60° field of view · 2212x1659 · handheld portable fundus camera image — 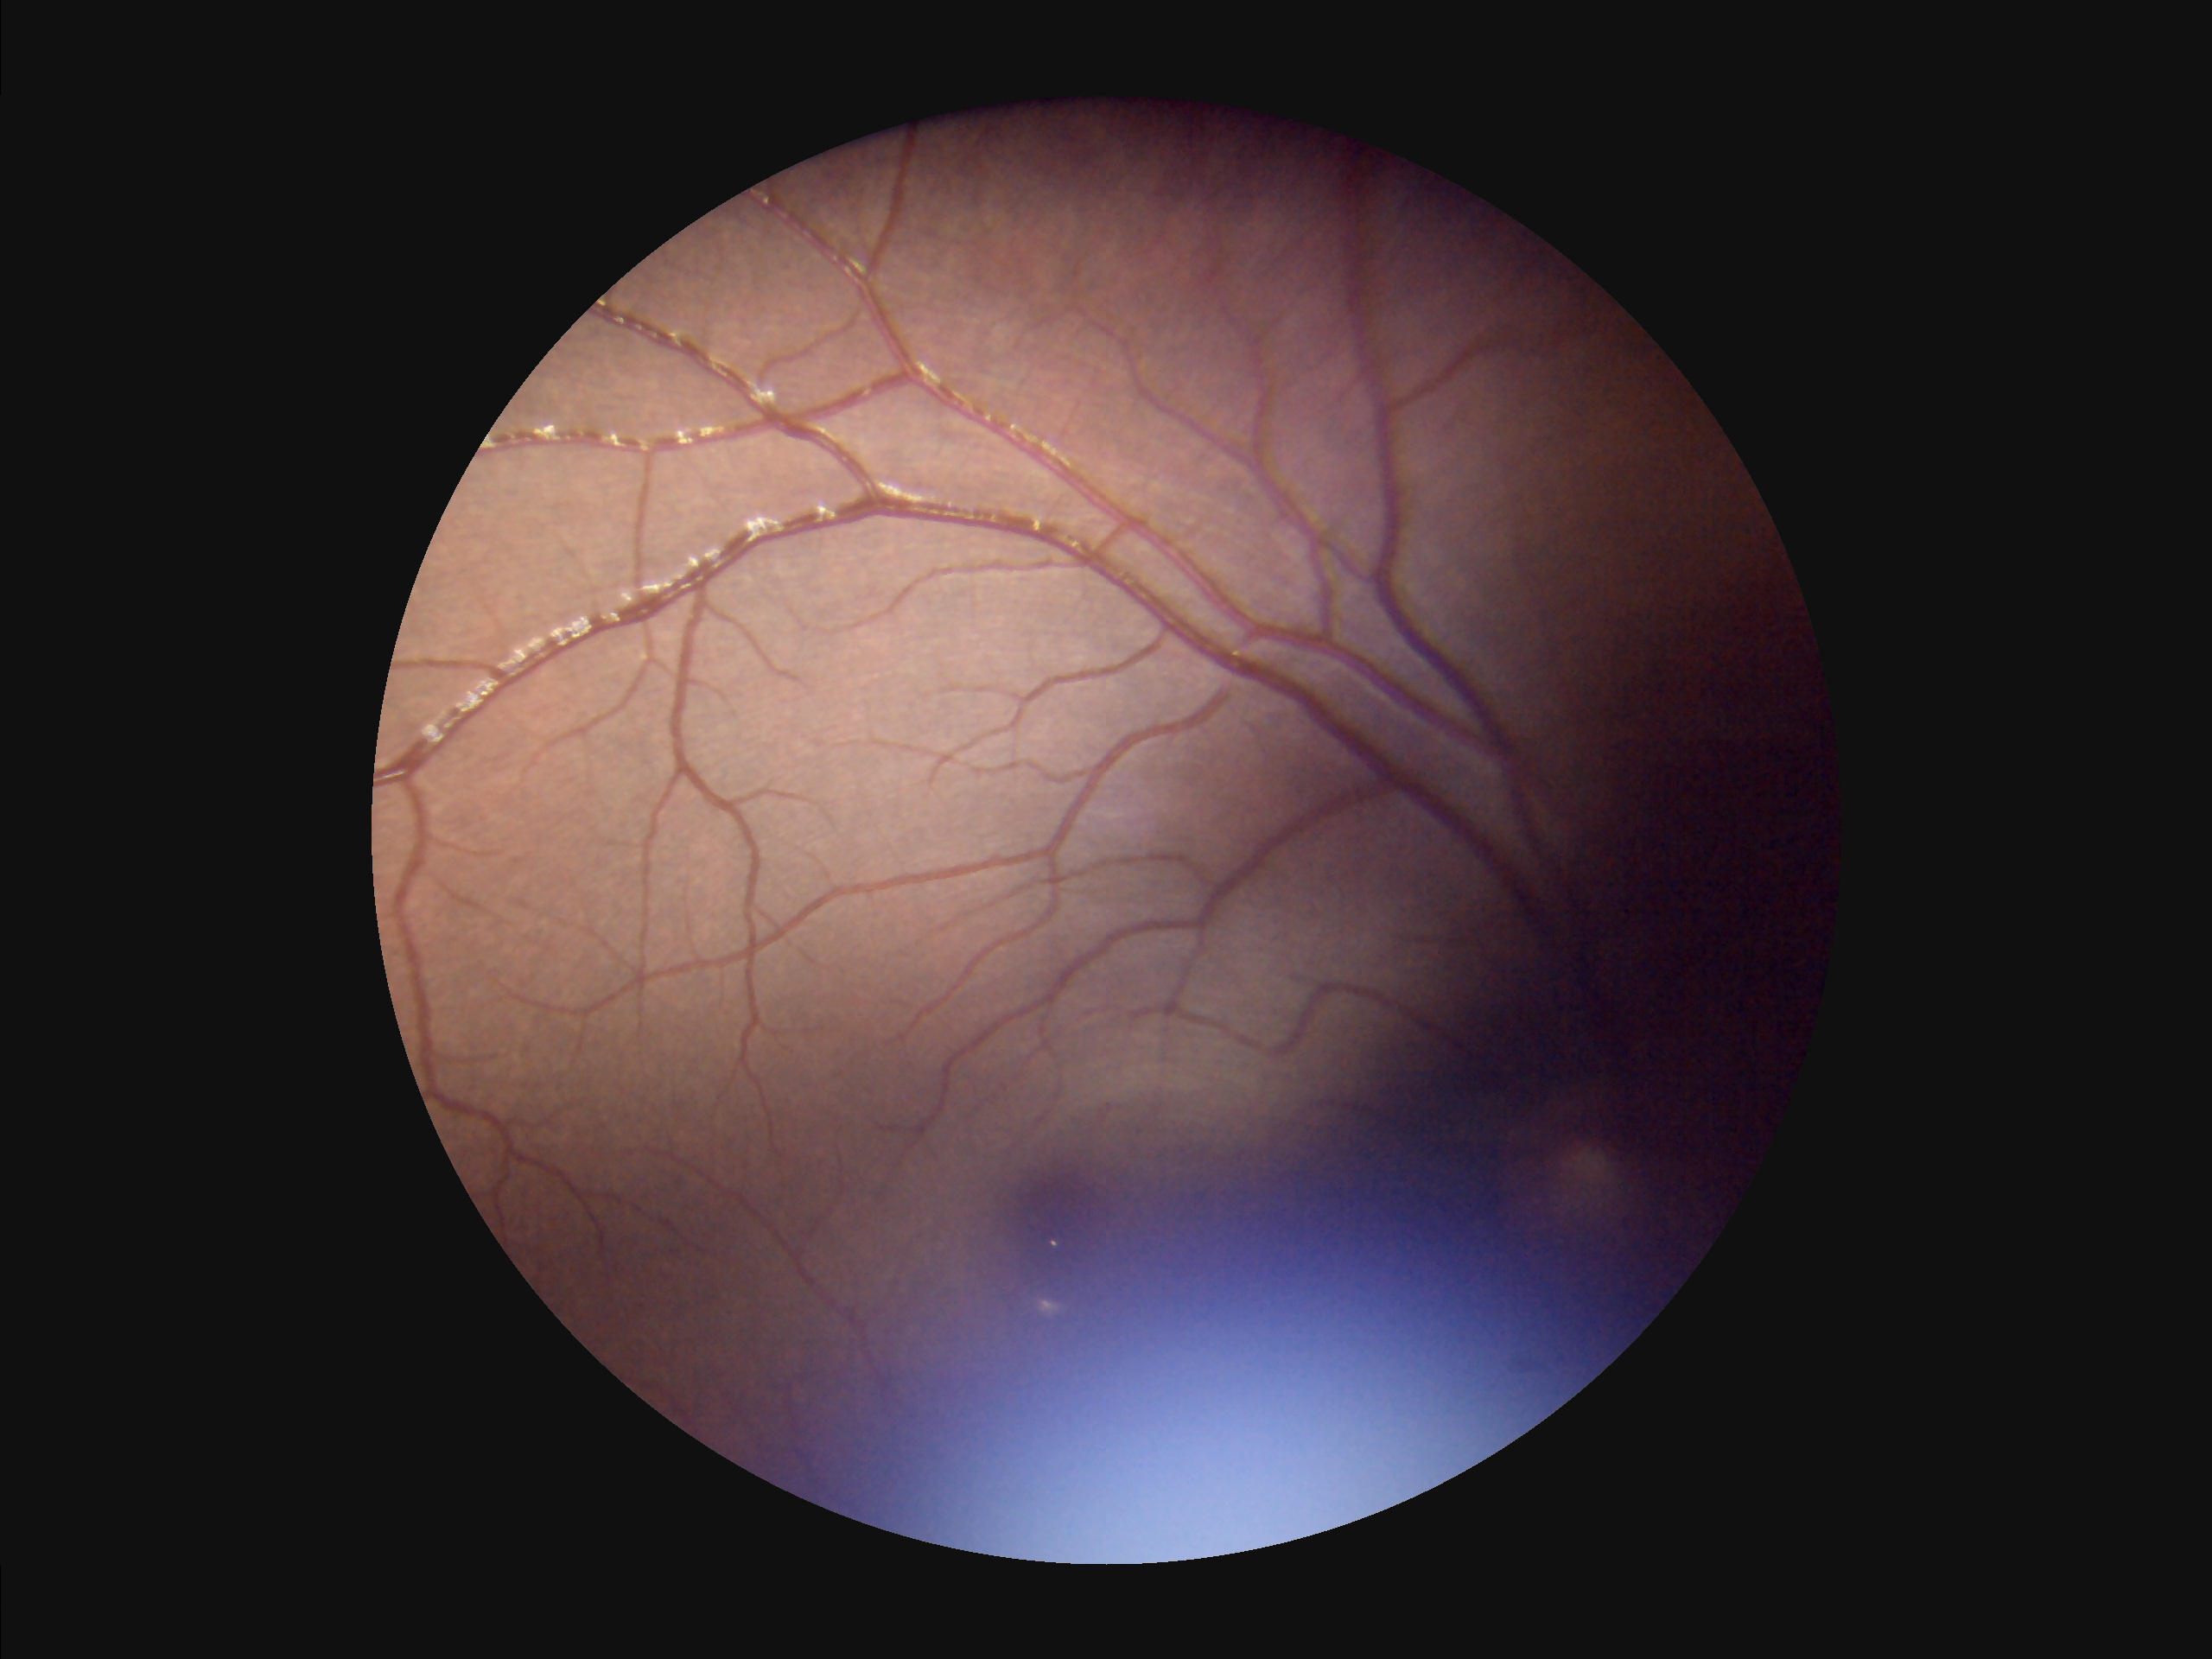
Image quality is inadequate for diagnostic use. There is over- or under-exposure or a color cast. Out of focus; structures are indistinct.